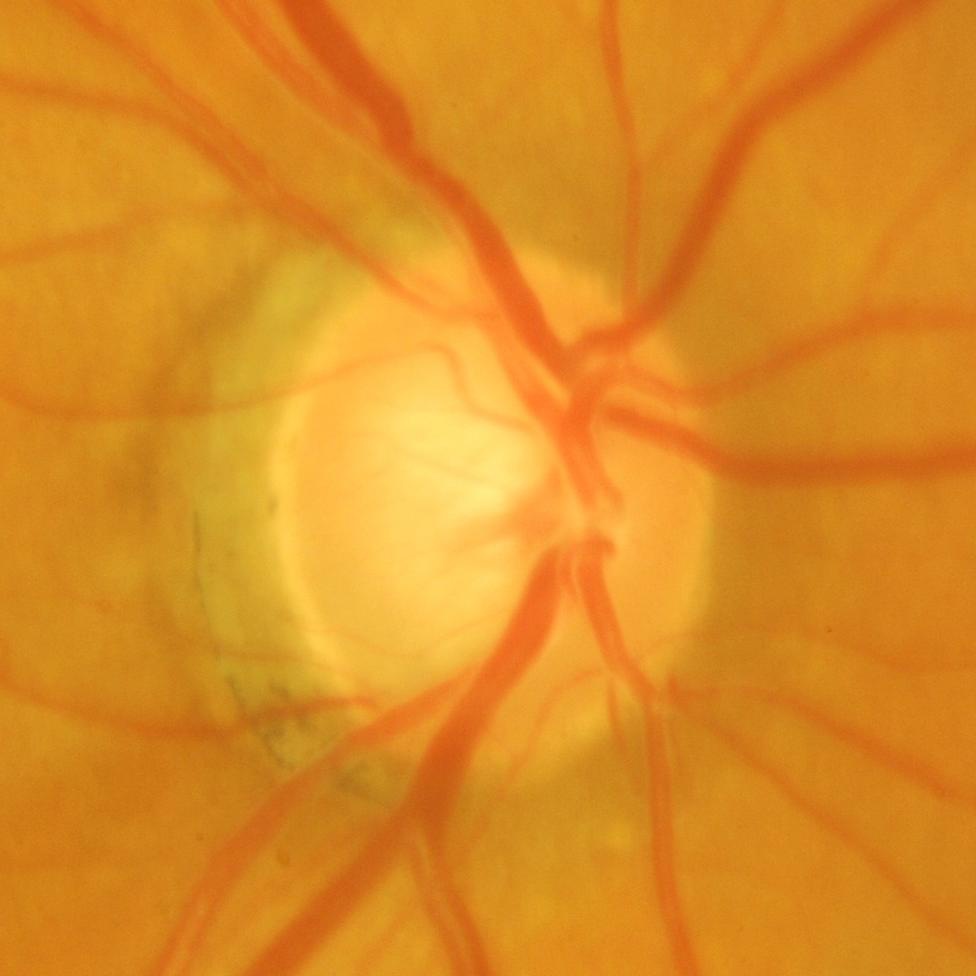
Optic nerve head photograph demonstrating glaucomatous damage to the optic nerve.